Davis DR grading
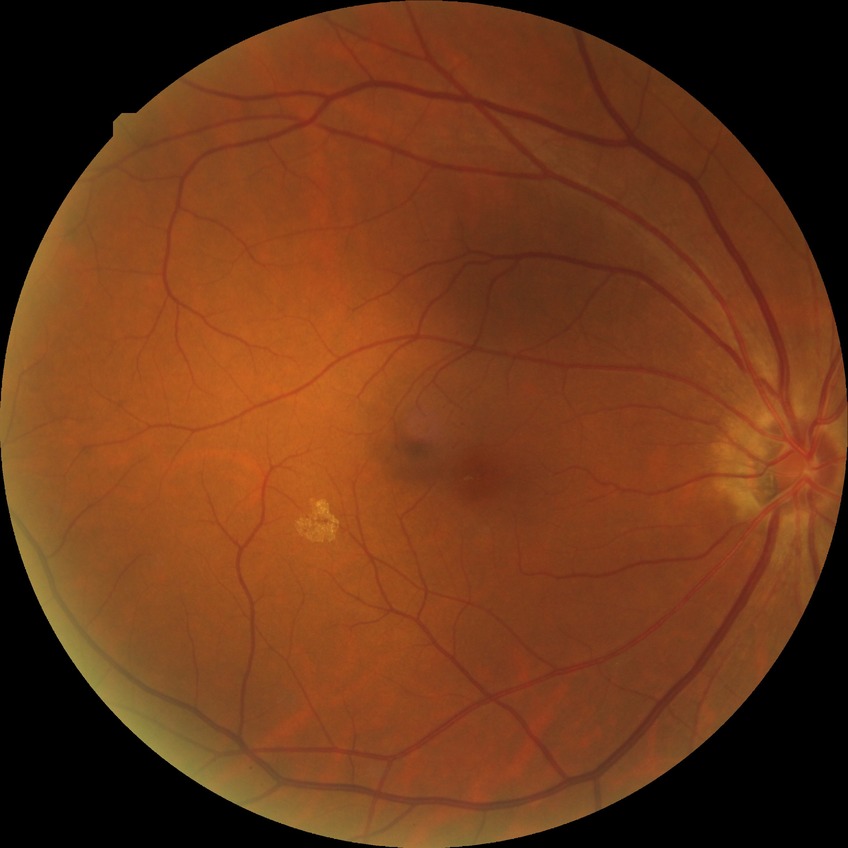

{"davis_grade": "no diabetic retinopathy"}